CFP.
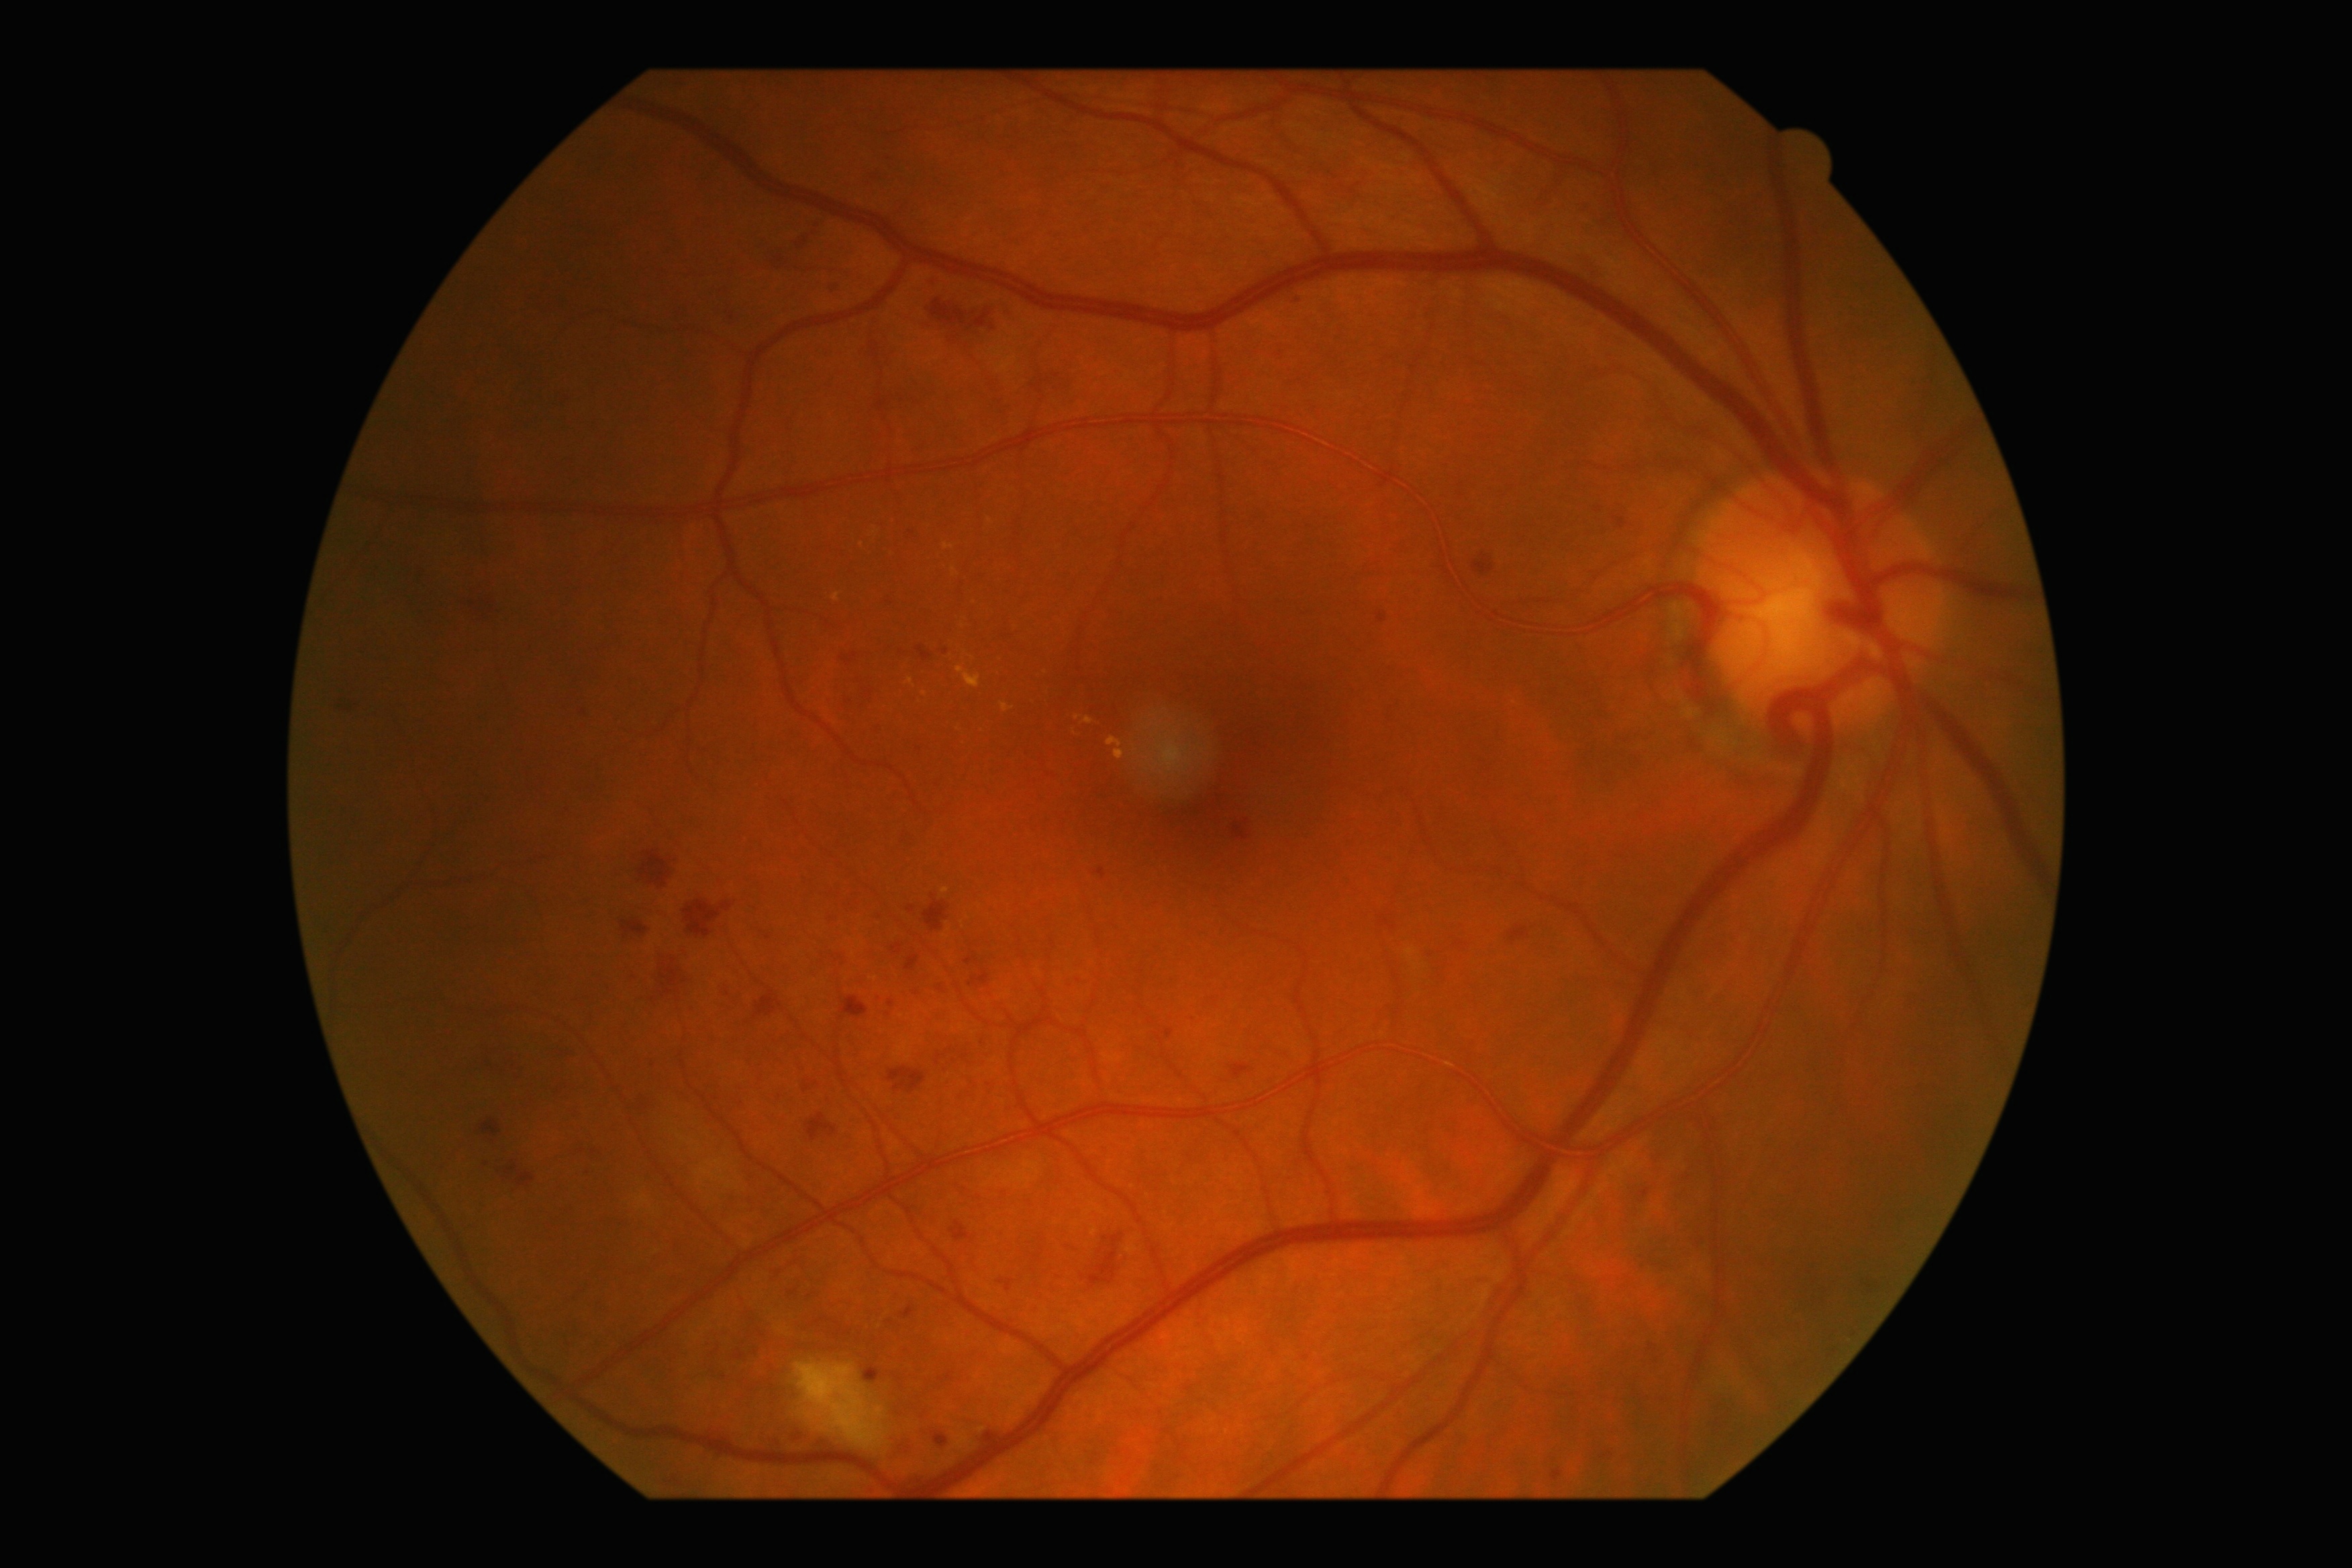 DR stage is grade 2 (moderate NPDR).